Infant wide-field fundus photograph — 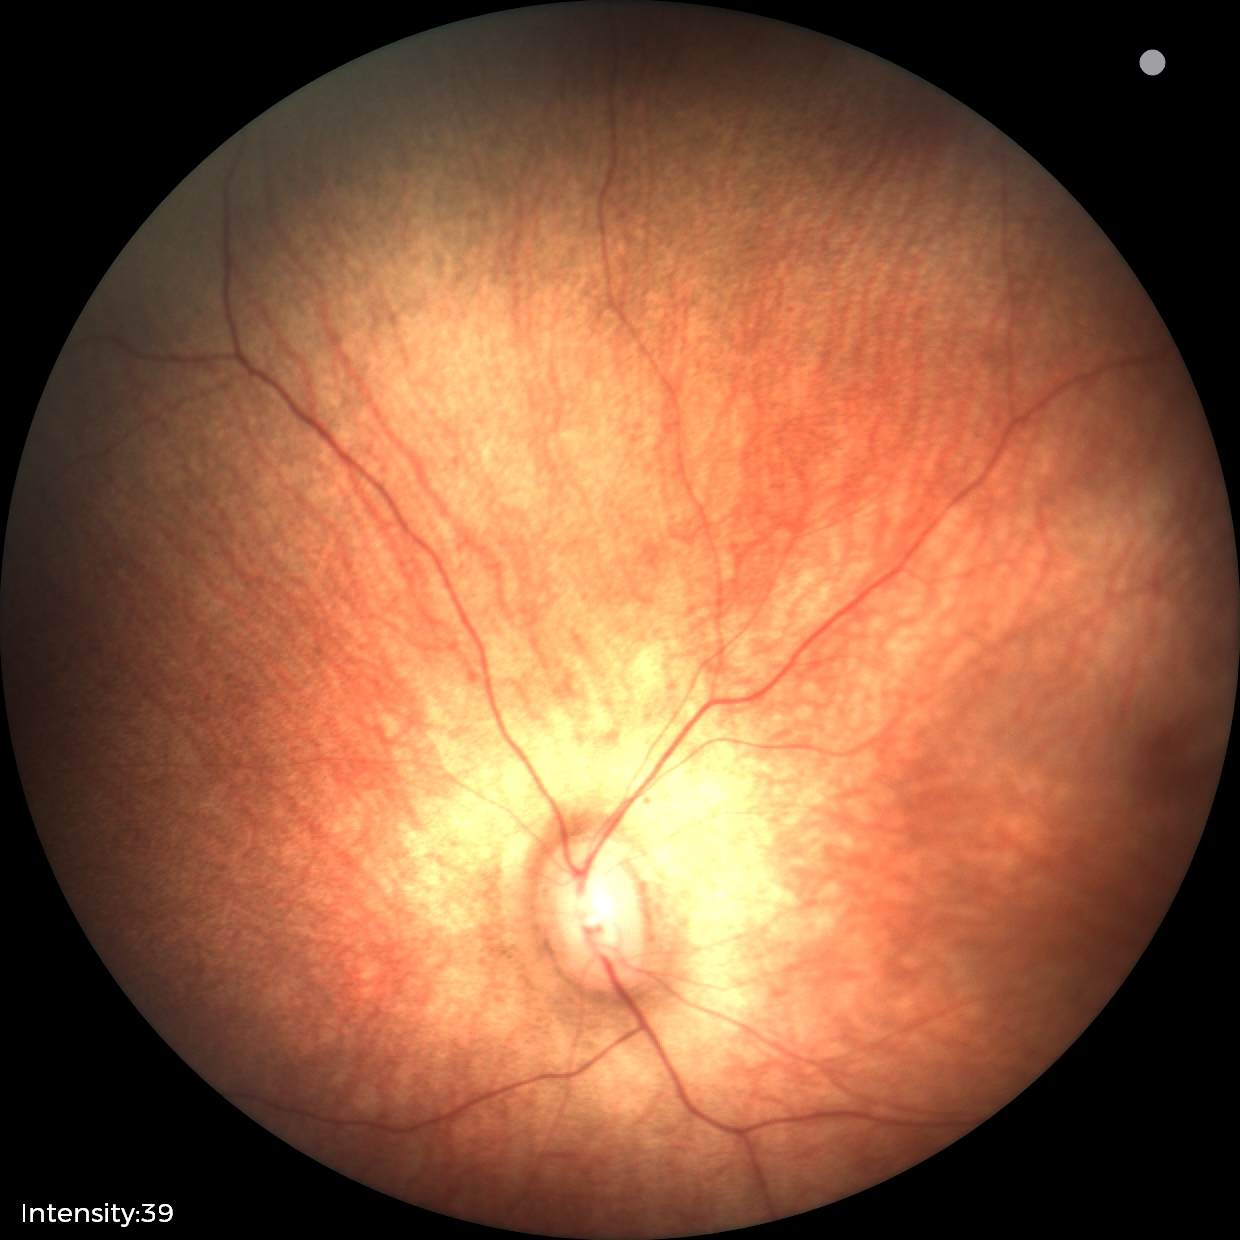

Finding = no abnormalities.